Captured on a Kowa VX-10α fundus camera — 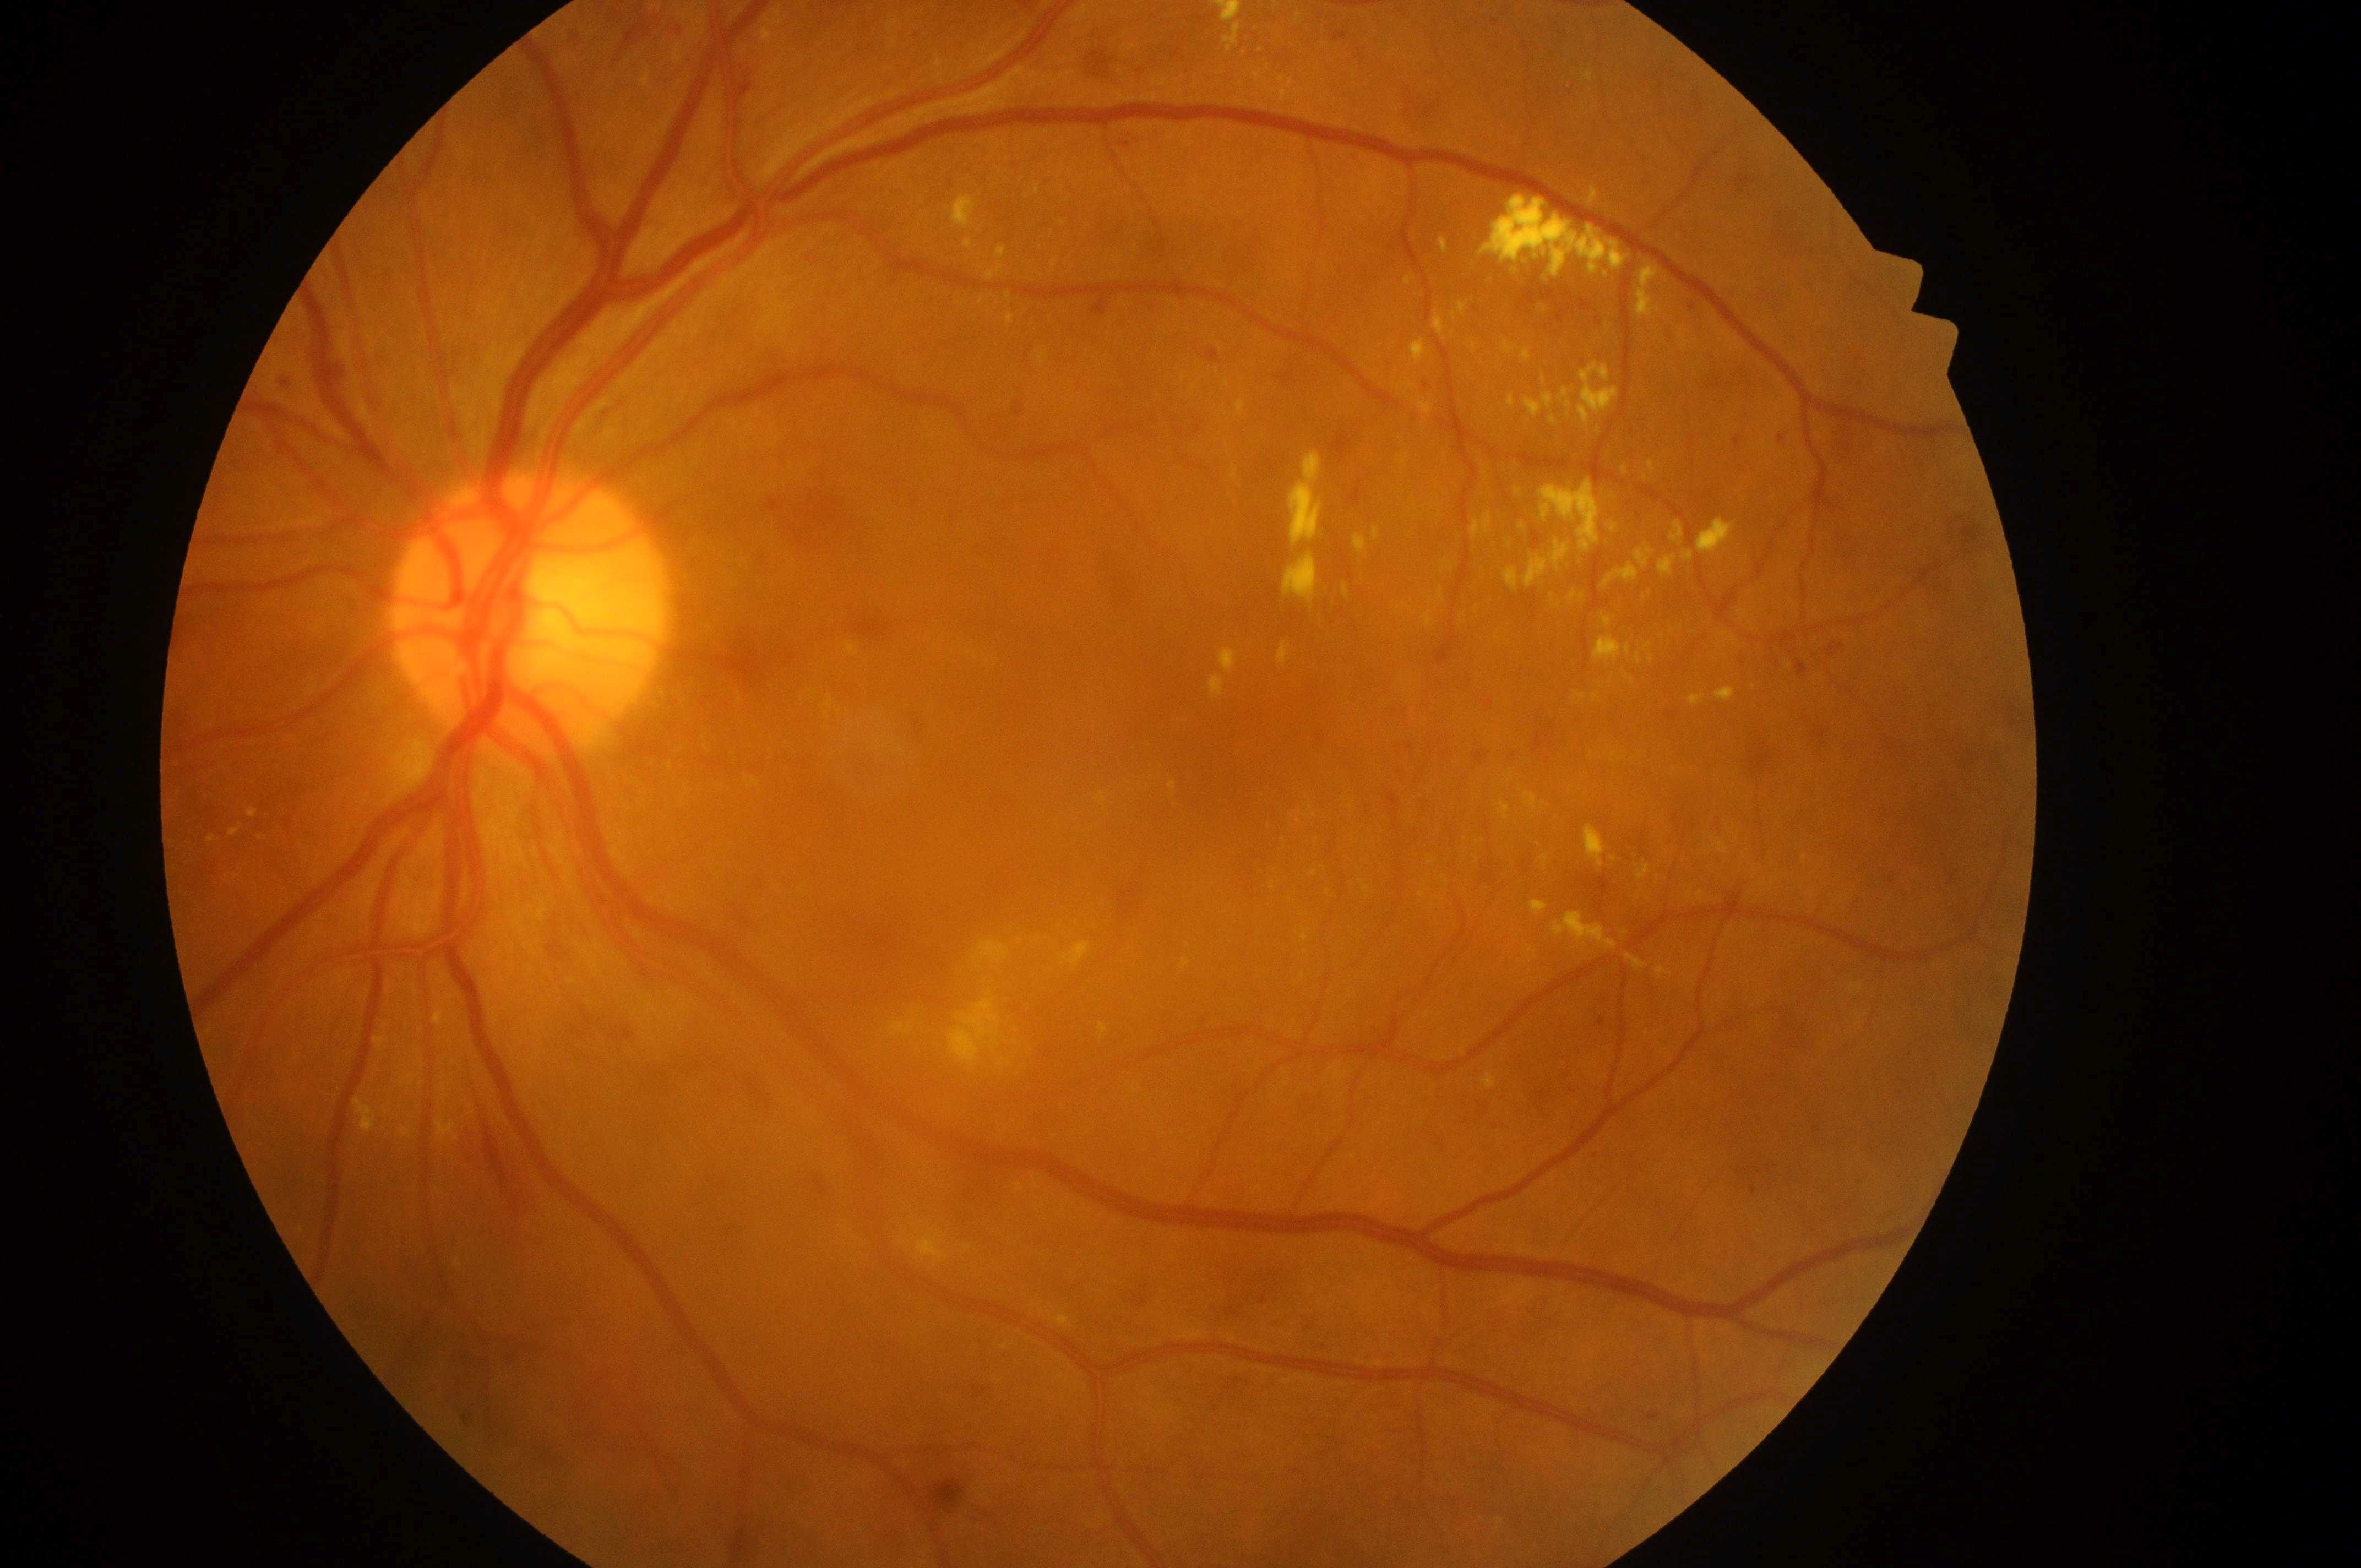

Q: Fovea center?
A: 1250, 732
Q: Where is the optic disc?
A: 519, 616
Q: What disease class is present?
A: non-proliferative diabetic retinopathy
Q: Which eye is imaged?
A: oculus sinister
Q: What is the DR grade?
A: severe non-proliferative diabetic retinopathy (grade 3)
Q: Macular edema risk?
A: grade 2 (high risk)